Color fundus image · 45 degree fundus photograph.
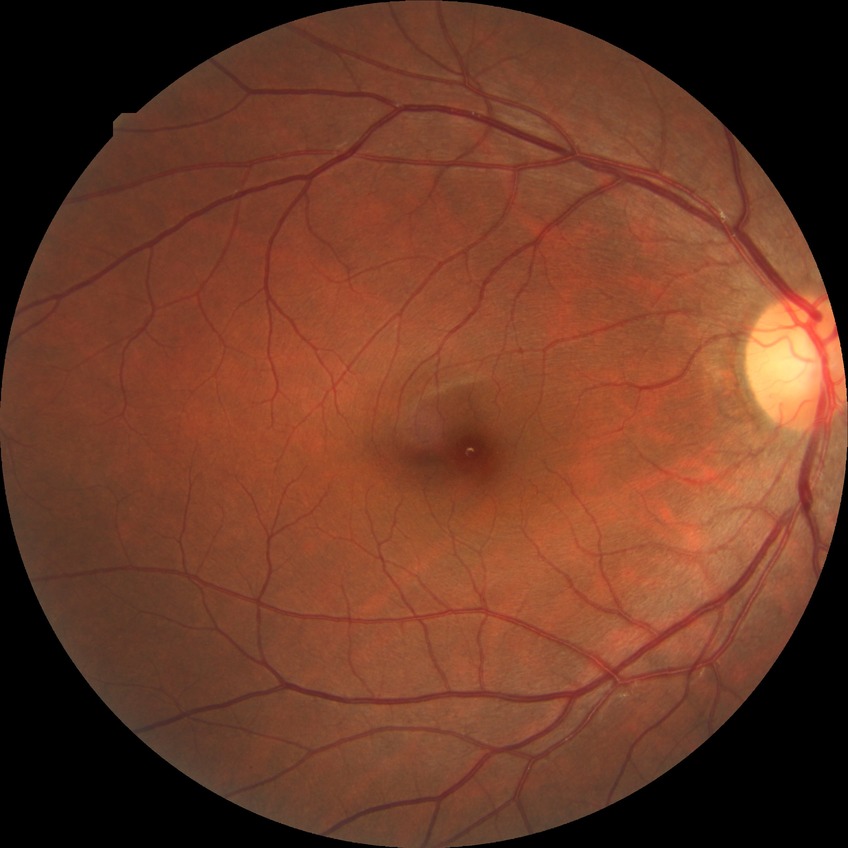
Diabetic retinopathy stage: no diabetic retinopathy.